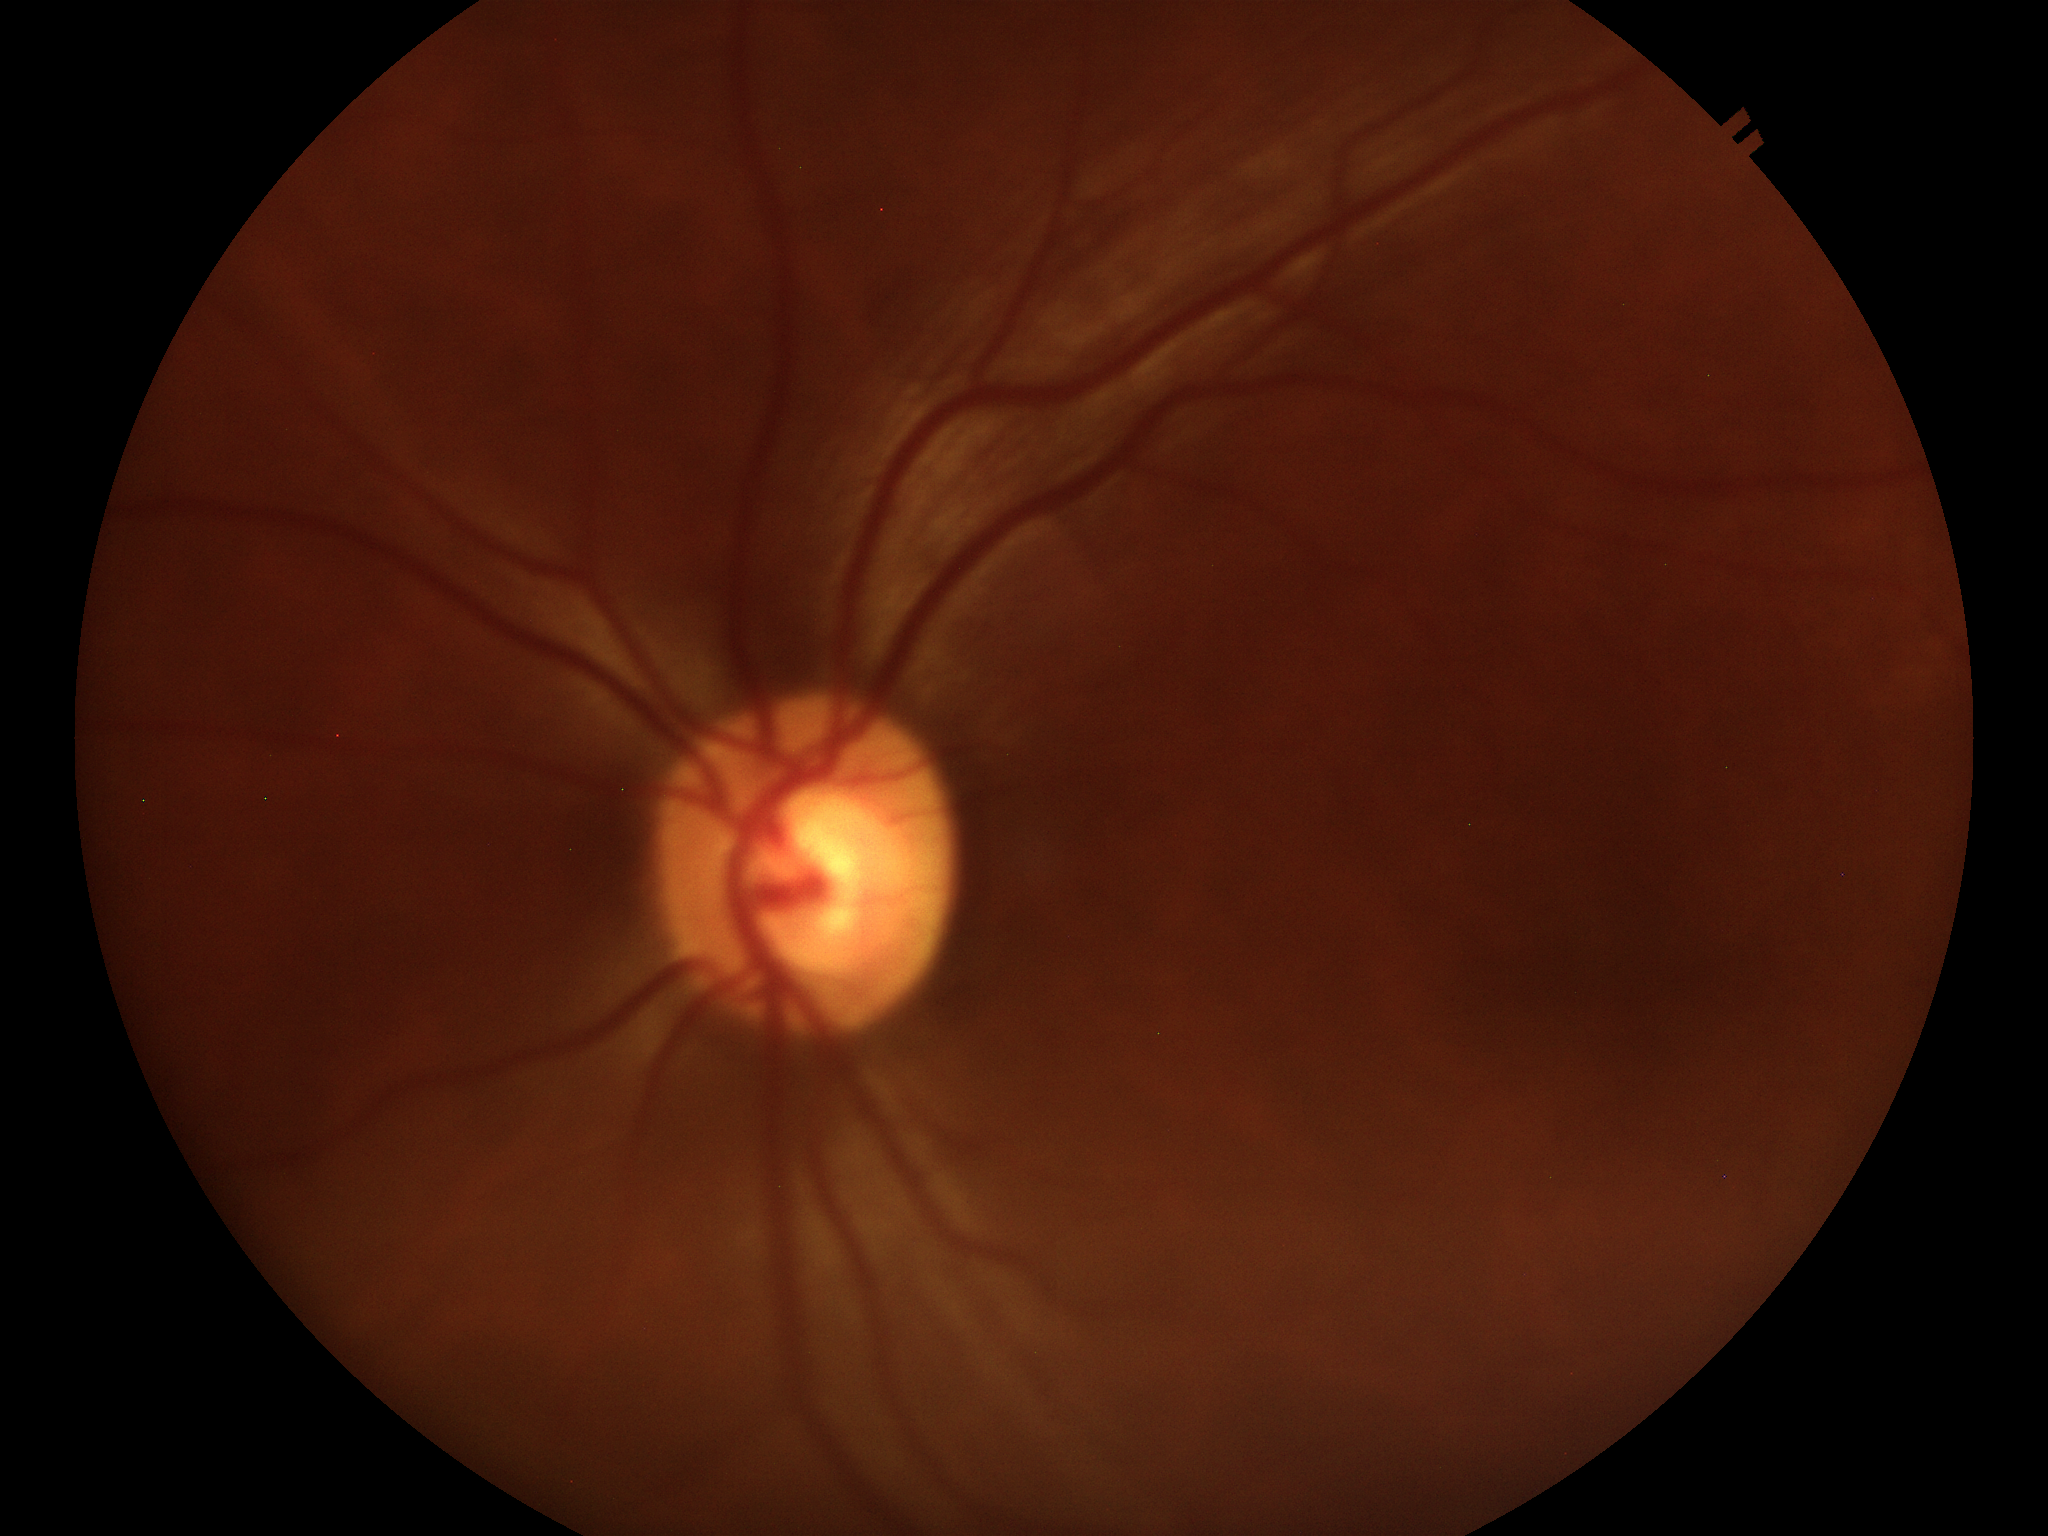
No evidence of glaucoma (two of five ophthalmologists flagged glaucoma suspect). Vertical CDR: 0.57. Area cup-to-disc ratio: 0.31. Horizontal cup-to-disc ratio is 0.56.